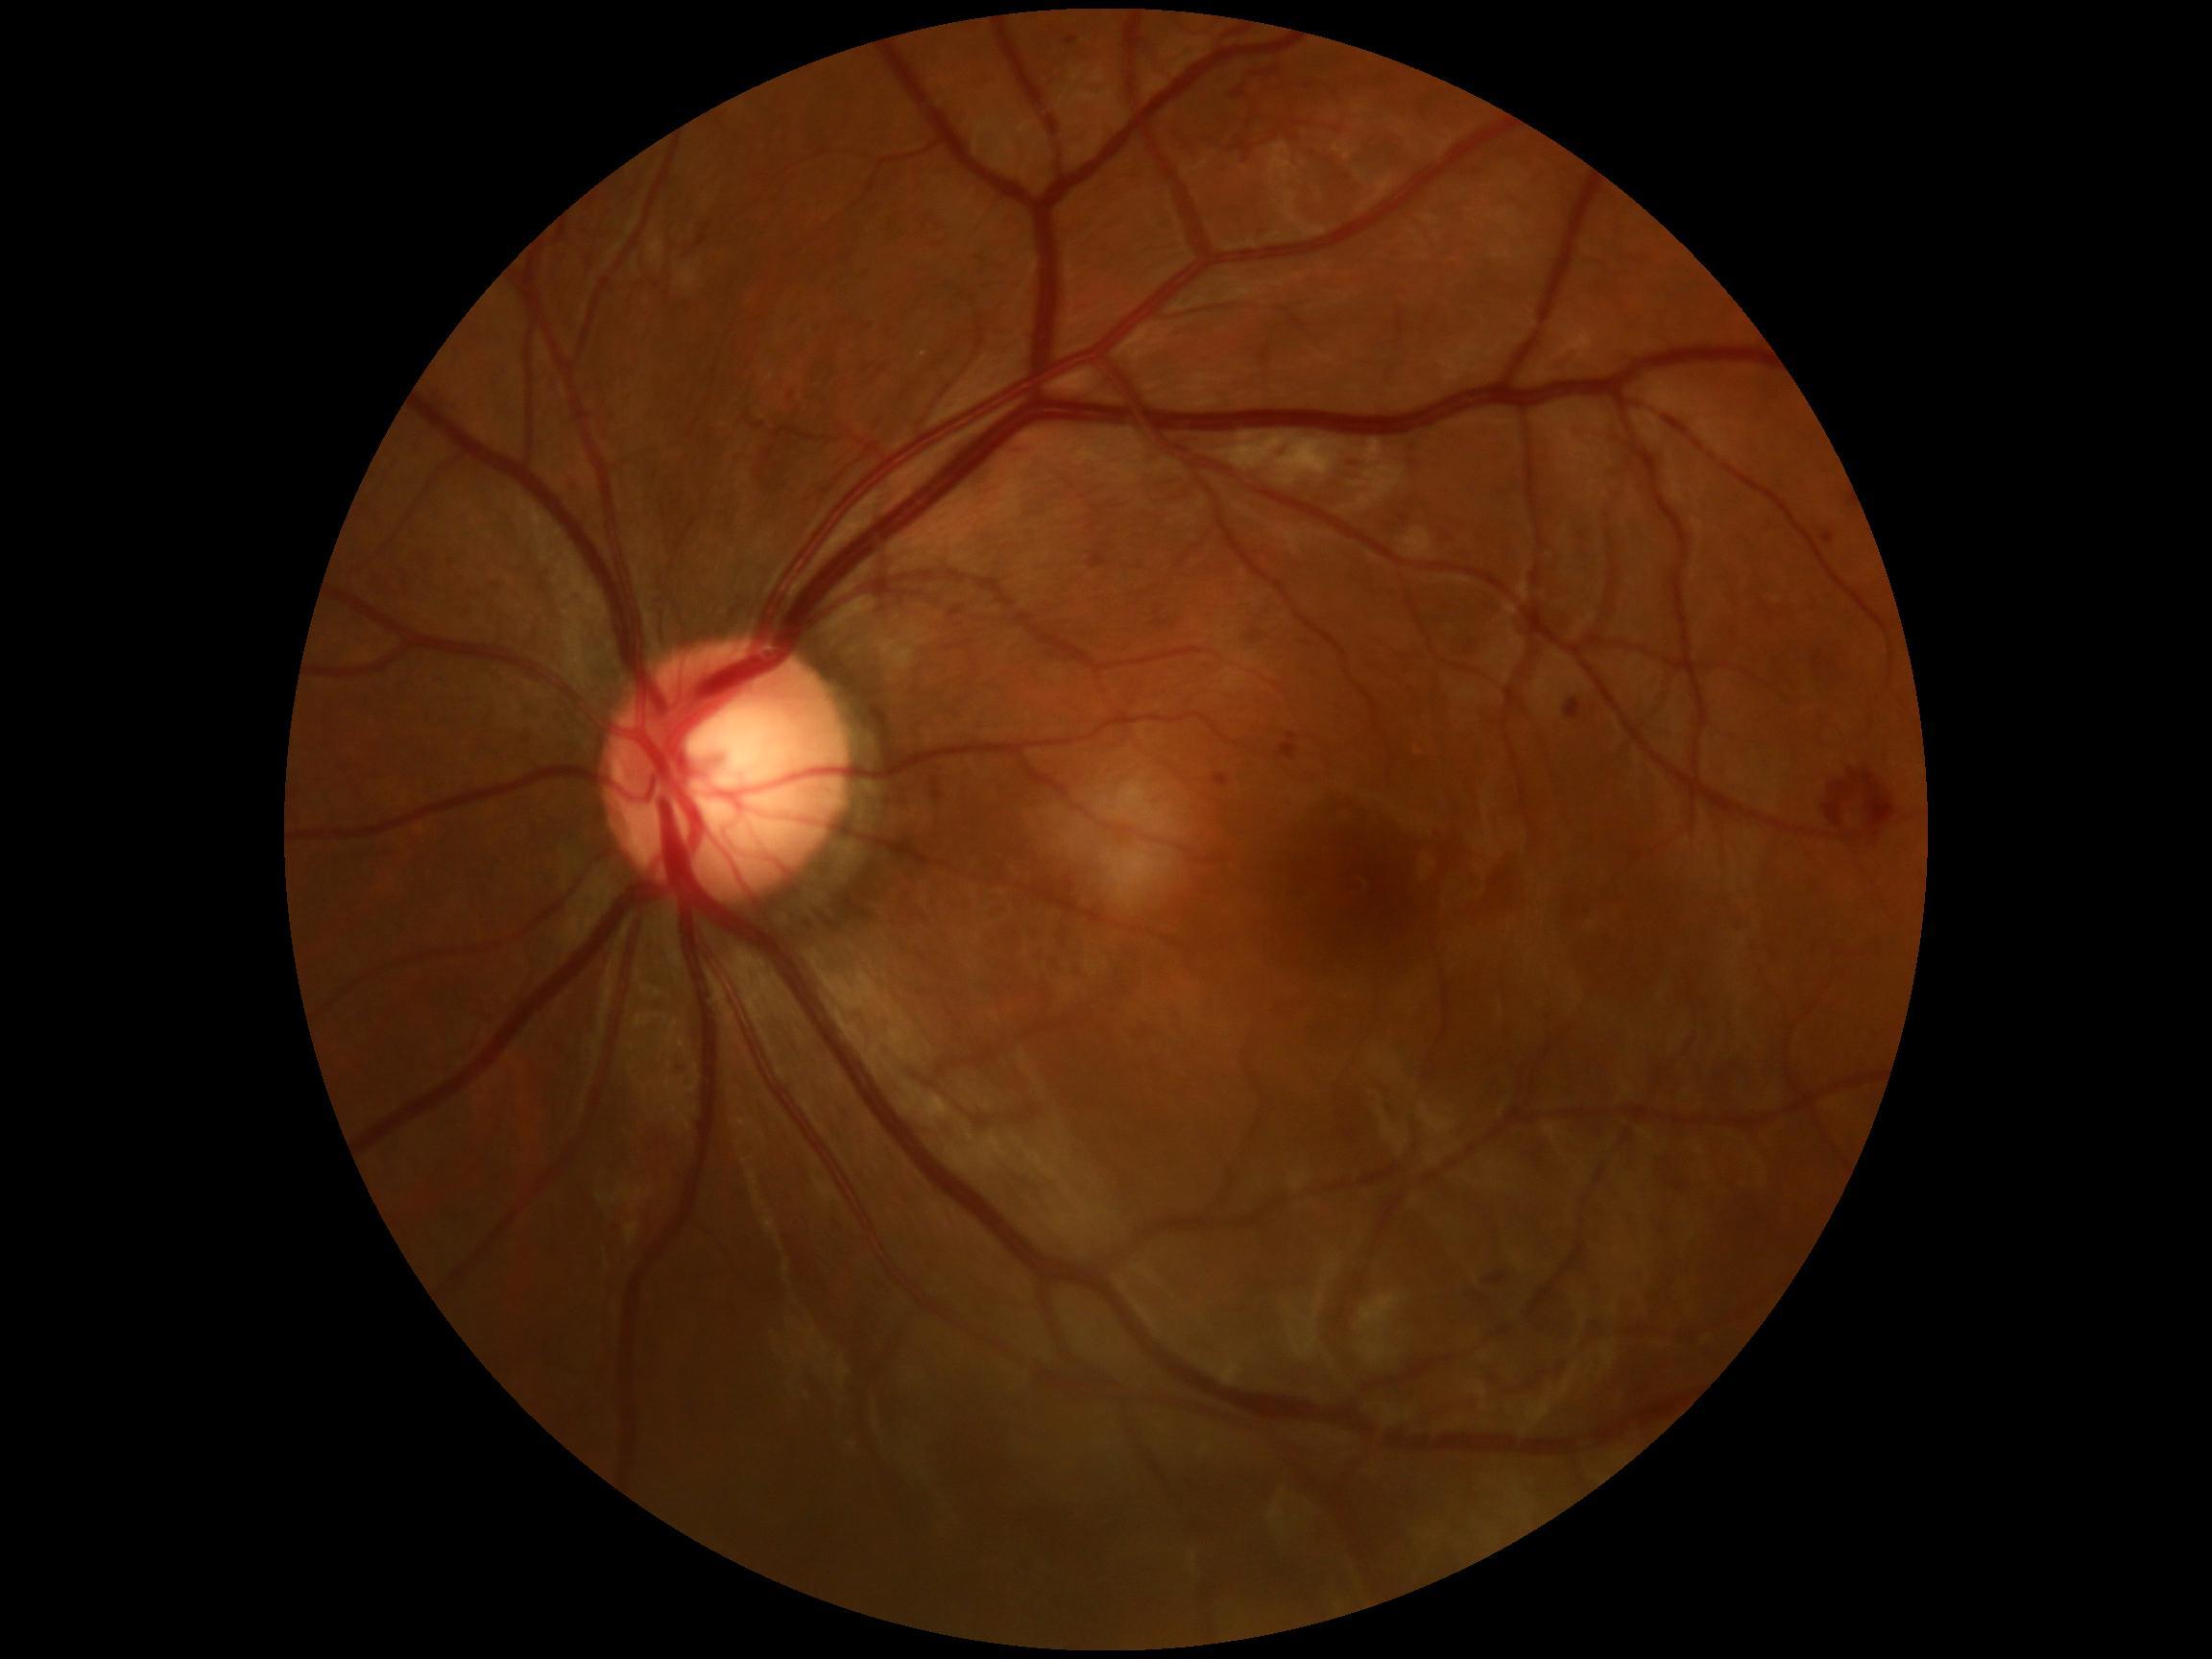
DR stage: 3 — more than 20 intraretinal hemorrhages in each of 4 quadrants, definite venous beading in 2 or more quadrants, or prominent intraretinal microvascular abnormalities in 1 or more quadrants, with no signs of proliferative retinopathy.